Fundus photo.
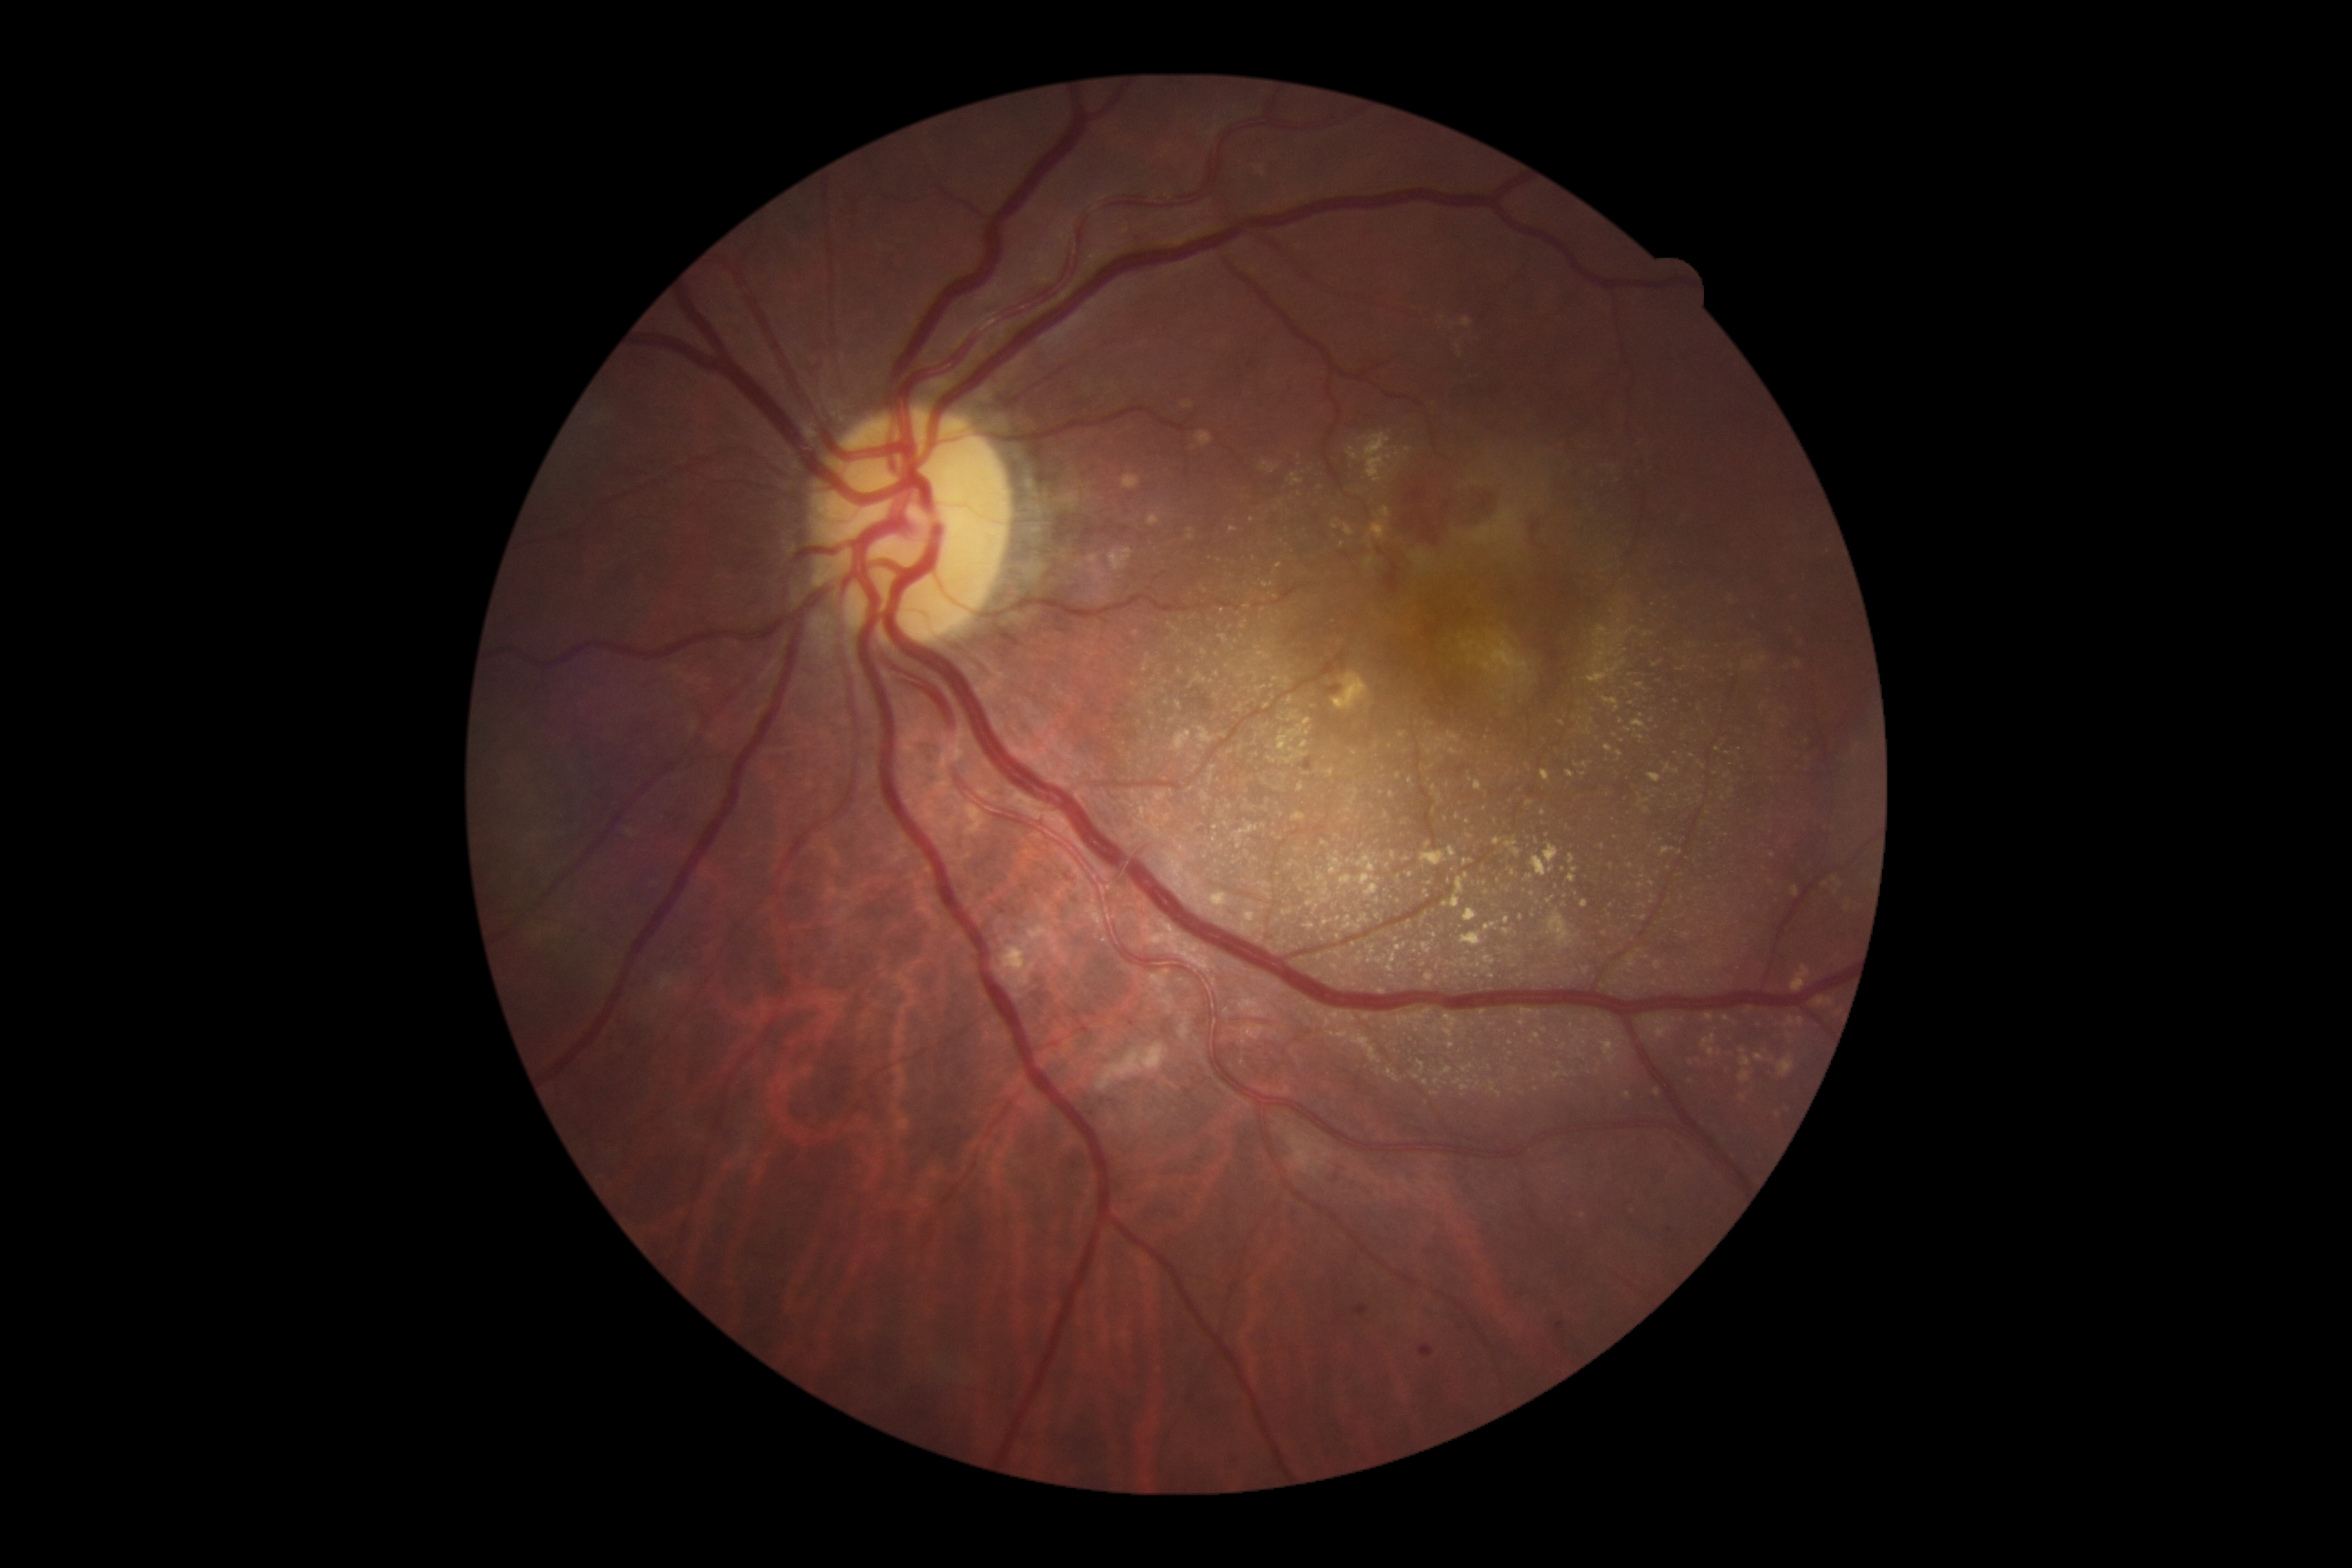
Diabetic retinopathy grade is 2/4.